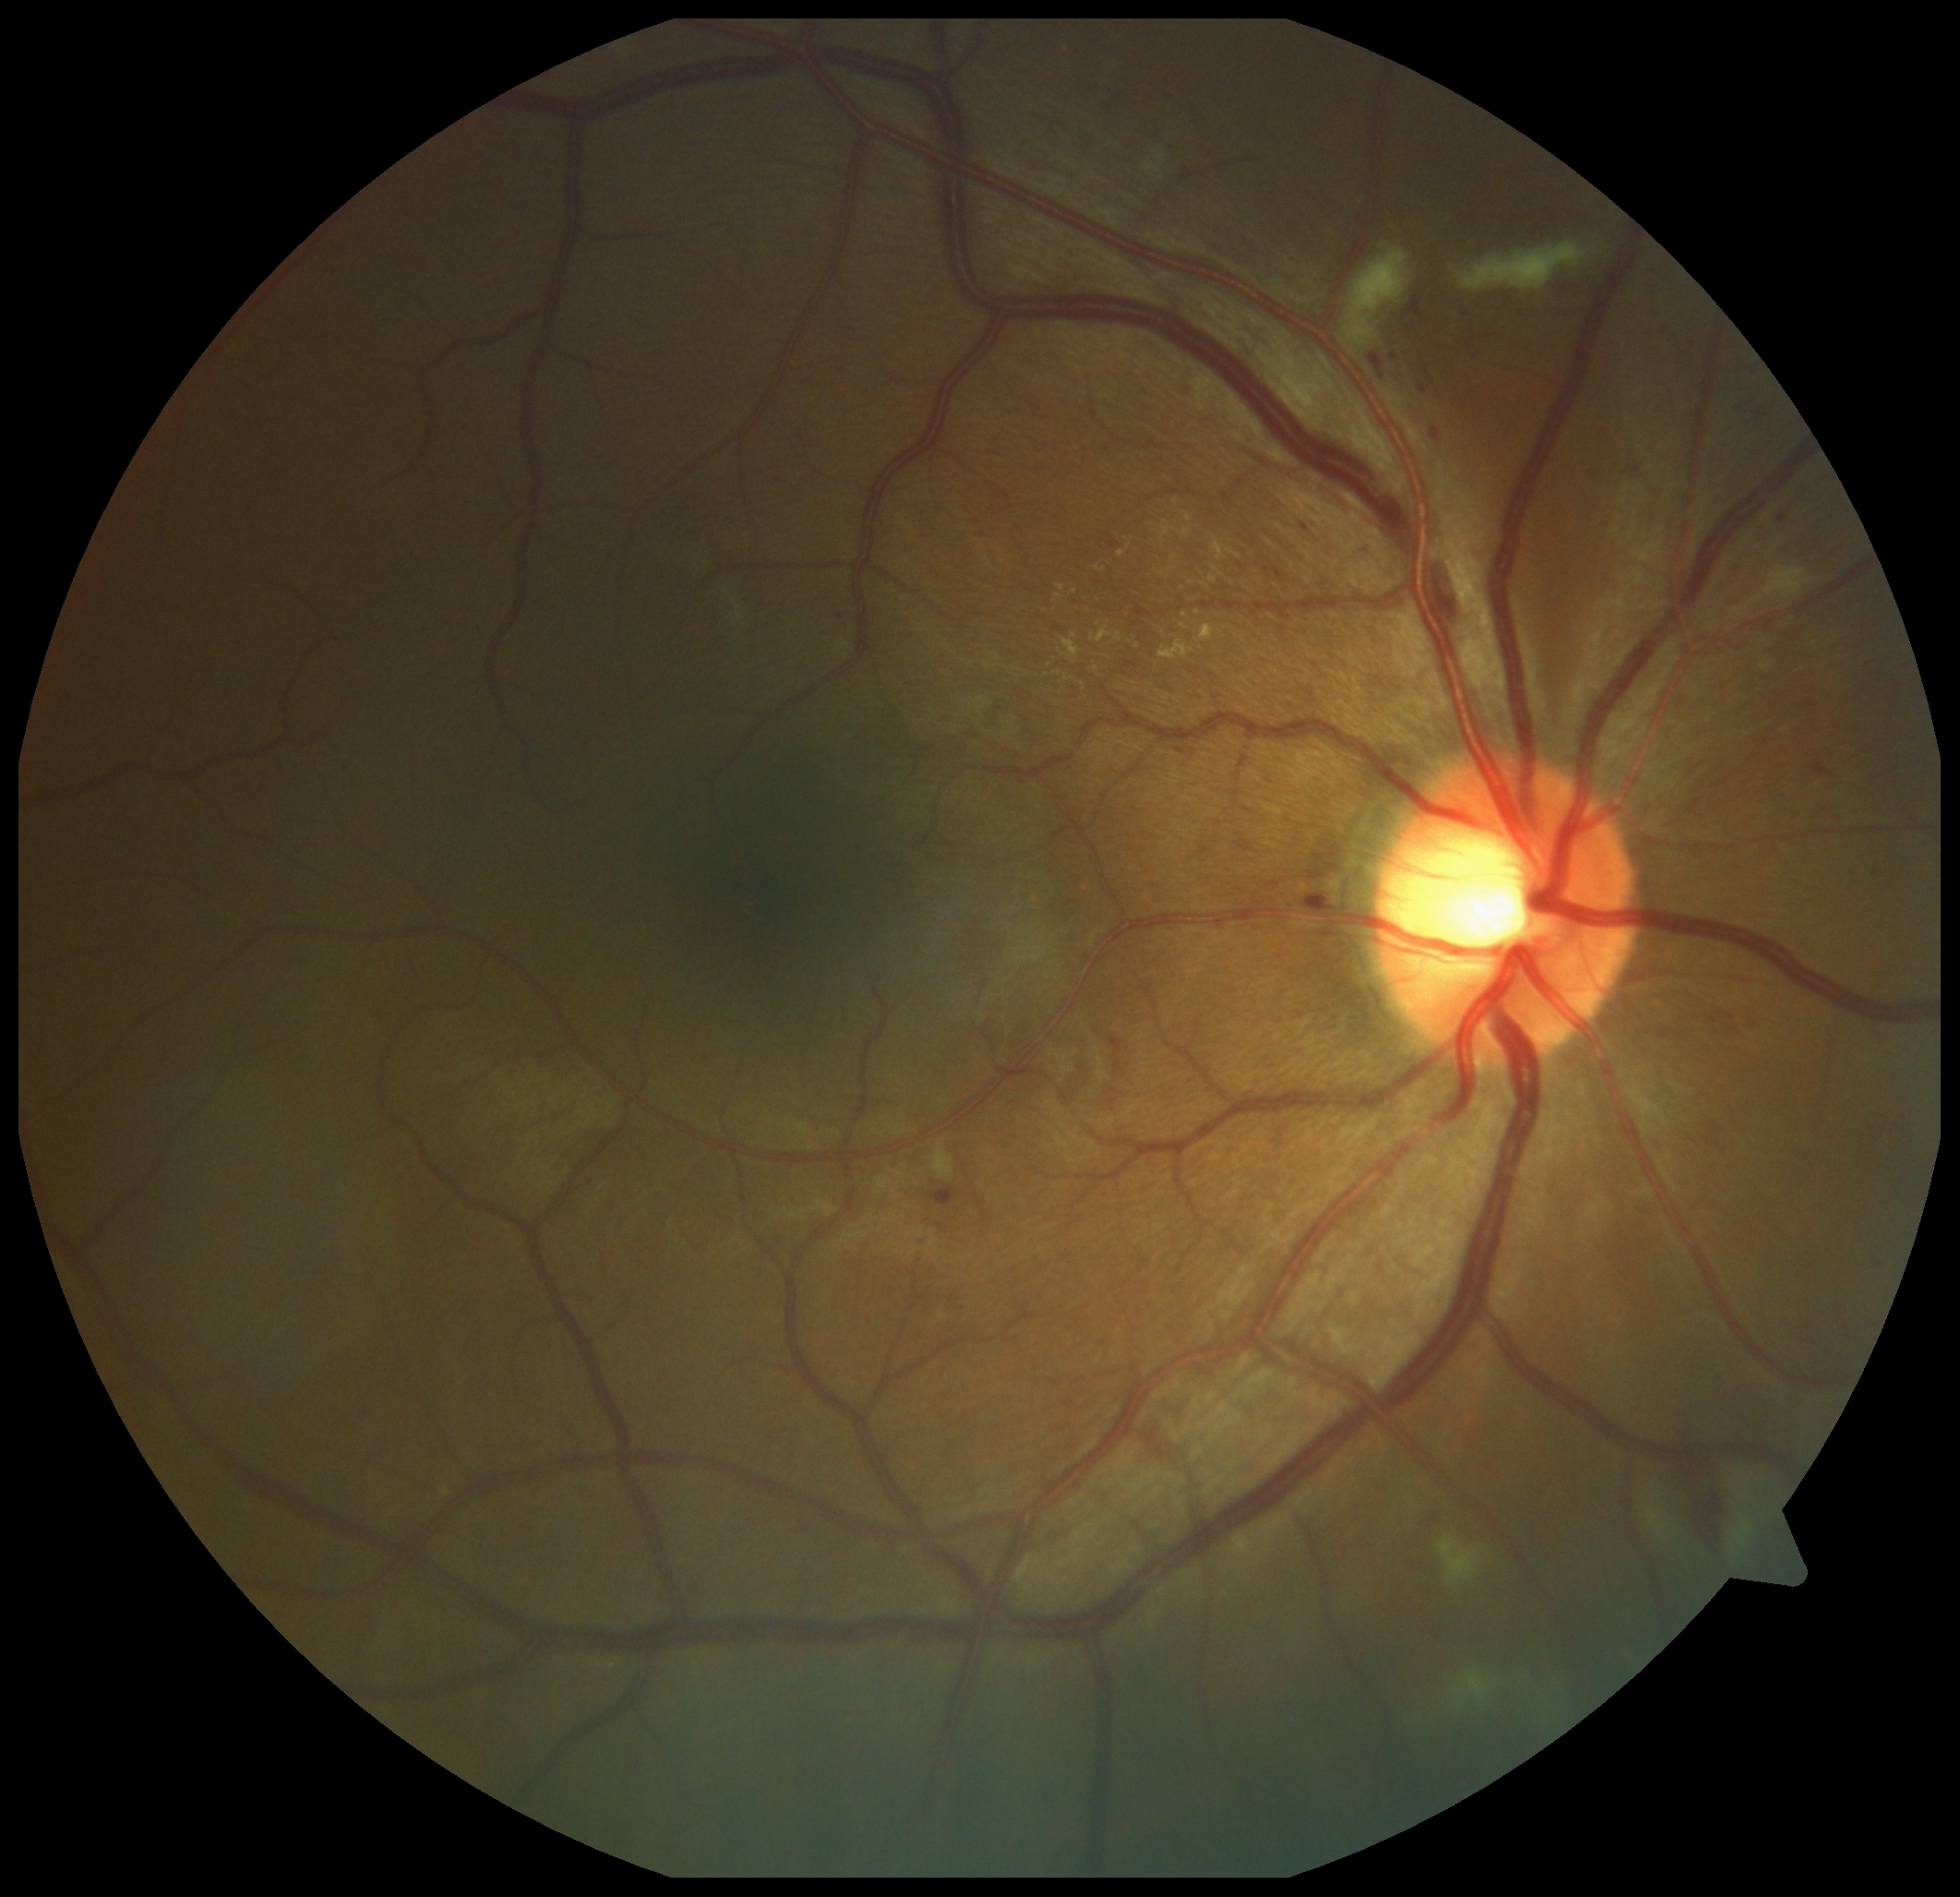

Diabetic retinopathy severity: grade 2 (moderate NPDR)
Selected lesions:
hemorrhages: <region>1671, 1462, 1729, 1565</region>
soft exudates (subset): <region>1154, 149, 1165, 162</region> | <region>1646, 1505, 1675, 1541</region> | <region>1346, 248, 1414, 346</region> | <region>1438, 1533, 1487, 1588</region> | <region>1731, 1521, 1753, 1554</region> | <region>1753, 566, 1811, 603</region> | <region>1145, 166, 1162, 173</region> | <region>935, 1144, 955, 1178</region> | <region>1452, 1670, 1498, 1713</region> | <region>1457, 241, 1597, 293</region> | <region>735, 603, 745, 620</region>
hard exudates (subset): <region>1117, 633, 1122, 643</region> | <region>1118, 547, 1129, 558</region> | <region>1058, 650, 1066, 658</region> | <region>1081, 682, 1087, 692</region> | <region>1162, 513, 1194, 538</region> | <region>1060, 633, 1081, 663</region> | <region>1096, 628, 1111, 645</region>
Additional small hard exudates near Point(1067, 679) | Point(1237, 556) | Point(1098, 568) | Point(1198, 612) | Point(1185, 616)
microaneurysms (subset): <region>1750, 1020, 1757, 1028</region> | <region>1814, 763, 1835, 778</region> | <region>1718, 1011, 1735, 1020</region> | <region>857, 847, 865, 855</region> | <region>1655, 324, 1667, 339</region> | <region>1423, 365, 1430, 376</region> | <region>1303, 892, 1336, 906</region> | <region>1713, 1124, 1724, 1135</region> | <region>1432, 427, 1440, 442</region> | <region>931, 1187, 959, 1208</region> | <region>1778, 513, 1789, 525</region>
Additional small microaneurysms near Point(995, 1456) | Point(1104, 1344) | Point(1637, 472) | Point(1409, 328) | Point(841, 616)